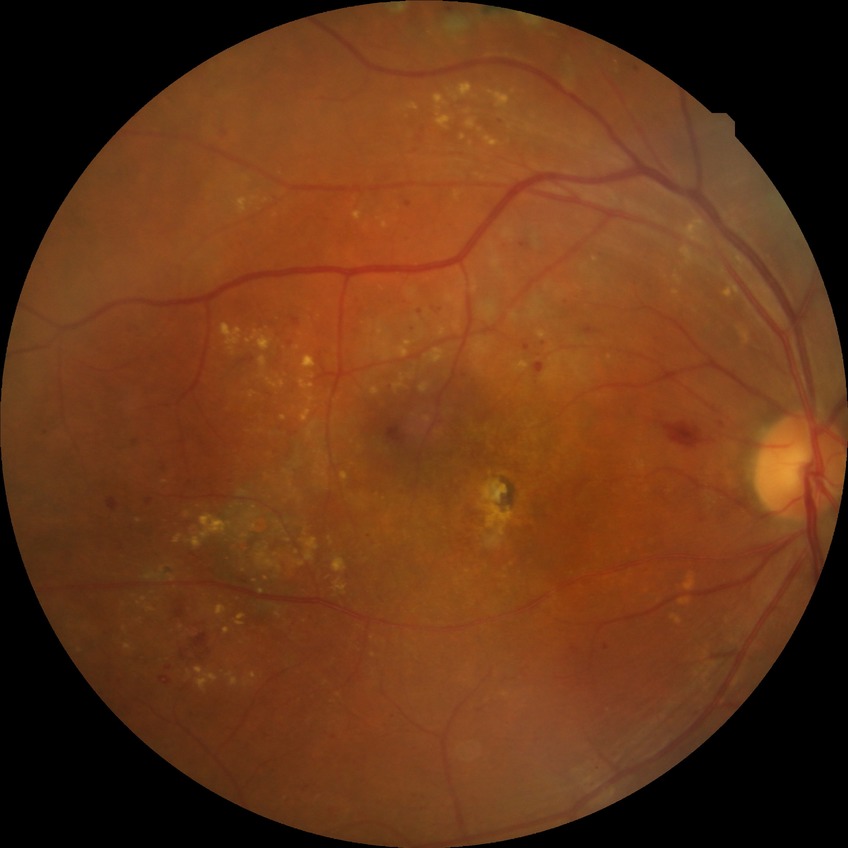

Assessment:
- diabetic retinopathy (DR) — PDR (proliferative diabetic retinopathy)